No pharmacologic dilation · graded on the modified Davis scale.
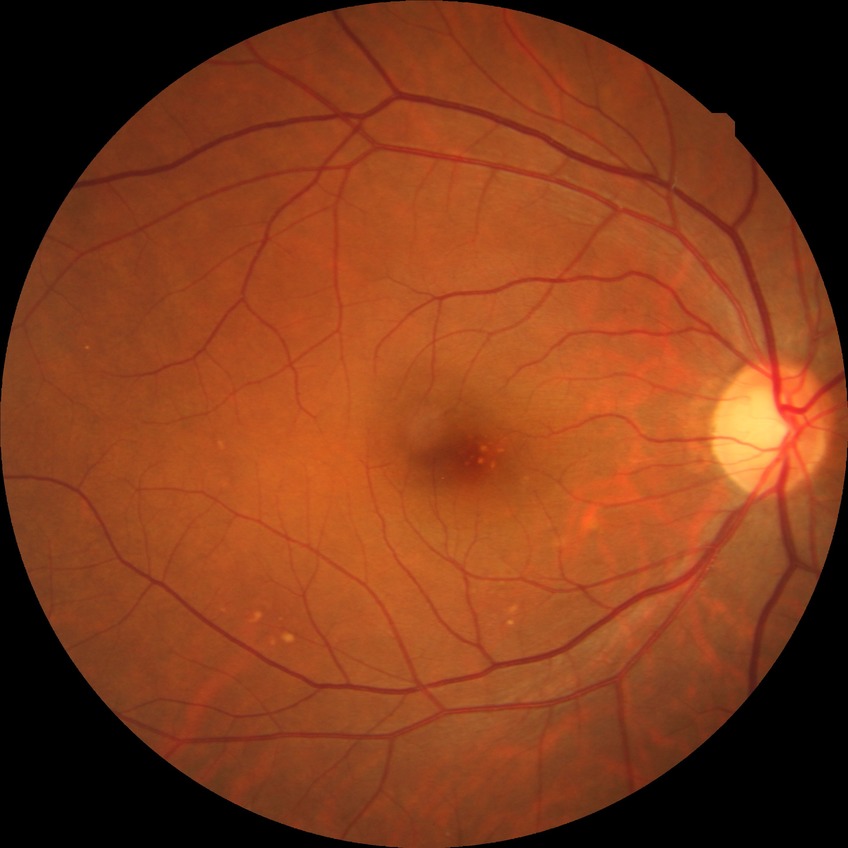 Diabetic retinopathy (DR) is NDR (no diabetic retinopathy).